Color fundus image; 45° FOV; camera: NIDEK AFC-230; image size 848x848; no pharmacologic dilation — 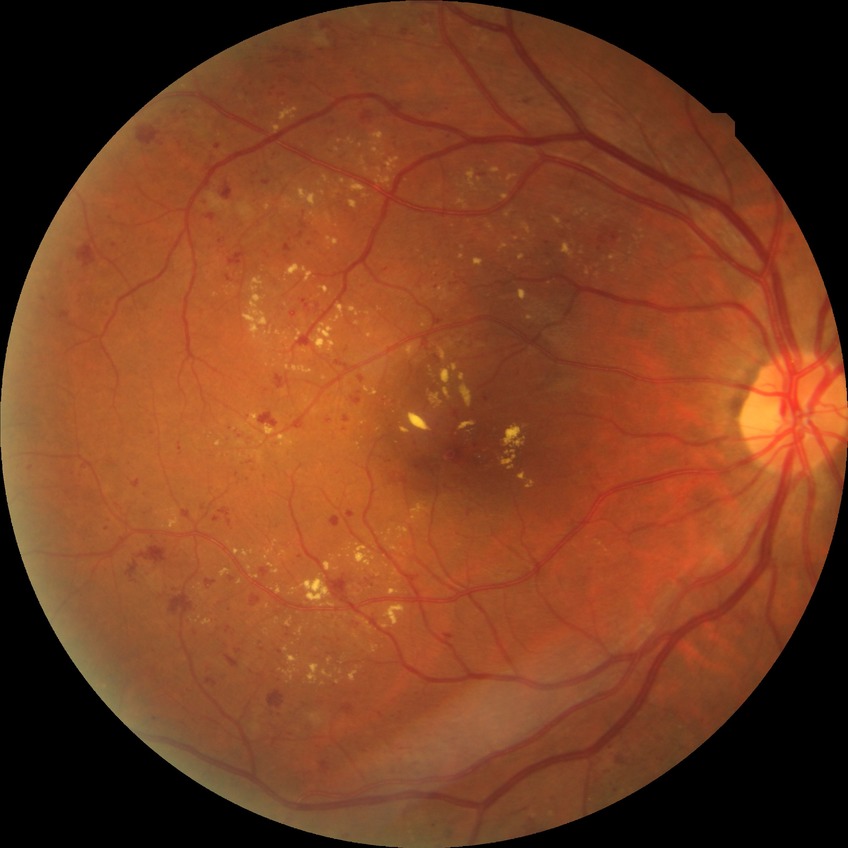 Diabetic retinopathy (DR) is SDR (simple diabetic retinopathy).
DR class: non-proliferative diabetic retinopathy.